Non-mydriatic acquisition. Optic nerve head crop. Nidek AFC-330:
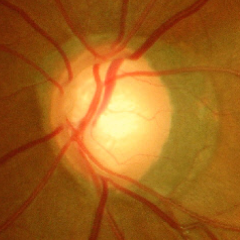
Findings consistent with glaucoma. Color fundus photograph showing severe glaucomatous damage.